45 degree fundus photograph. NIDEK AFC-230 fundus camera. Without pupil dilation
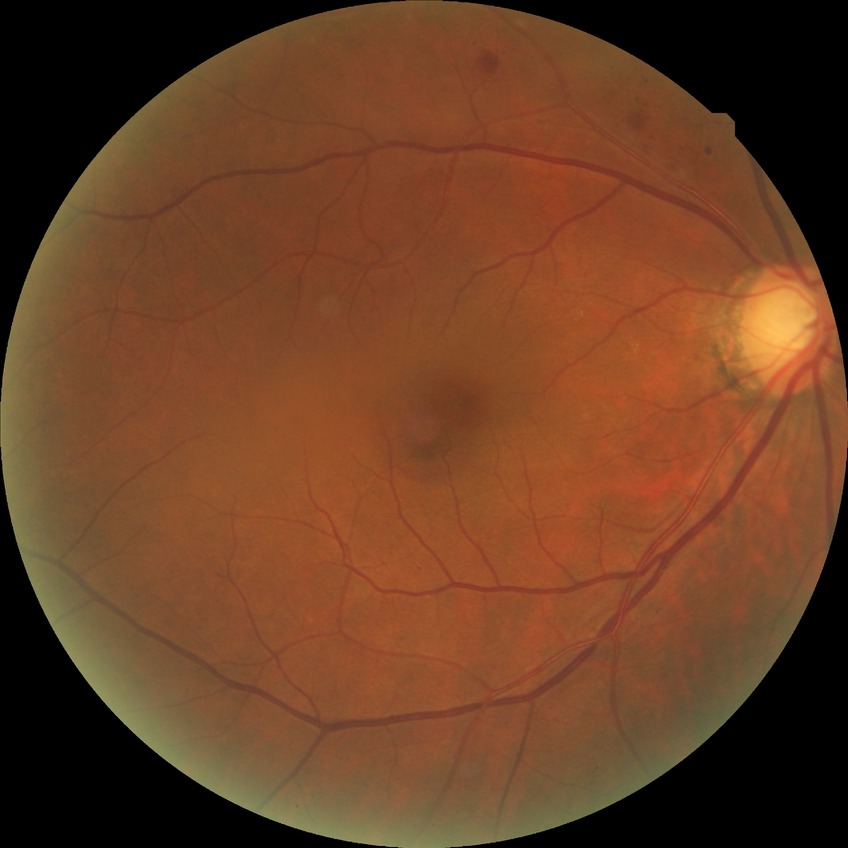
DR=PPDR.